Retinal fundus photograph, 45° field of view:
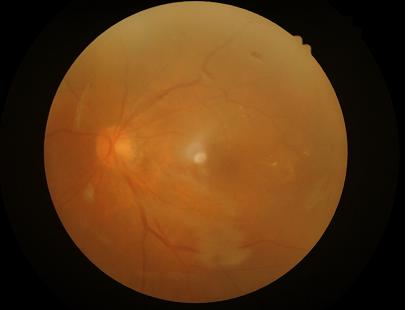
Image quality:
- illumination: over- or under-exposed
- clarity: noticeable blur in the optic disc, vessels, or background
- overall: inadequate for clinical interpretation
- contrast: good dynamic range